Color fundus image · Nidek AFC-330
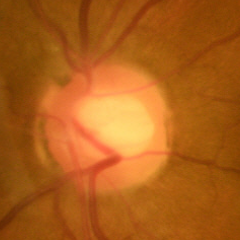 No glaucomatous optic neuropathy.